Captured with the Clarity RetCam 3 (130° field of view). Wide-field fundus photograph from neonatal ROP screening — 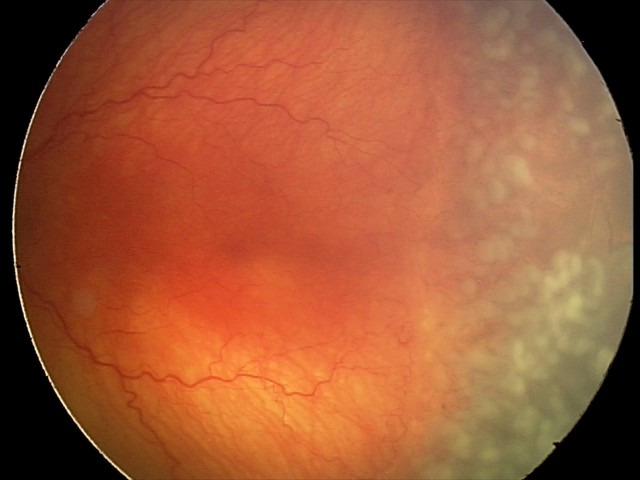
Plus disease = present — abnormal dilation and tortuosity of the posterior pole retinal vessels
screening diagnosis = aggressive retinopathy of prematurity (A-ROP)